Wide-field fundus image from infant ROP screening: 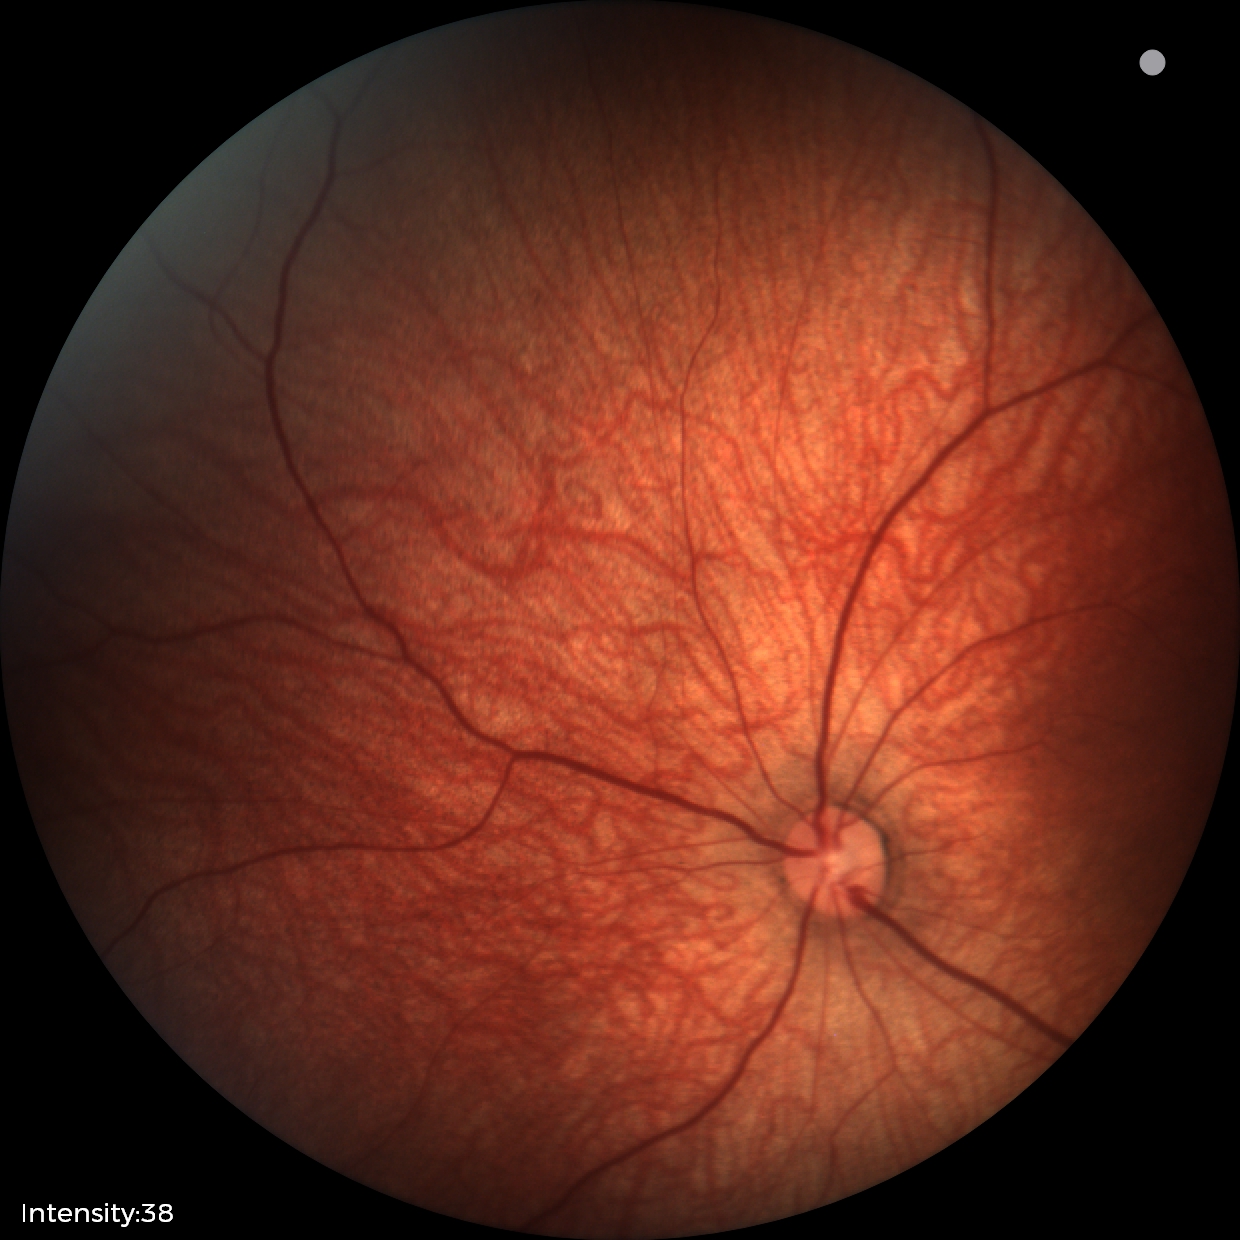

Q: What is the diagnosis from this examination?
A: normal retinal appearance